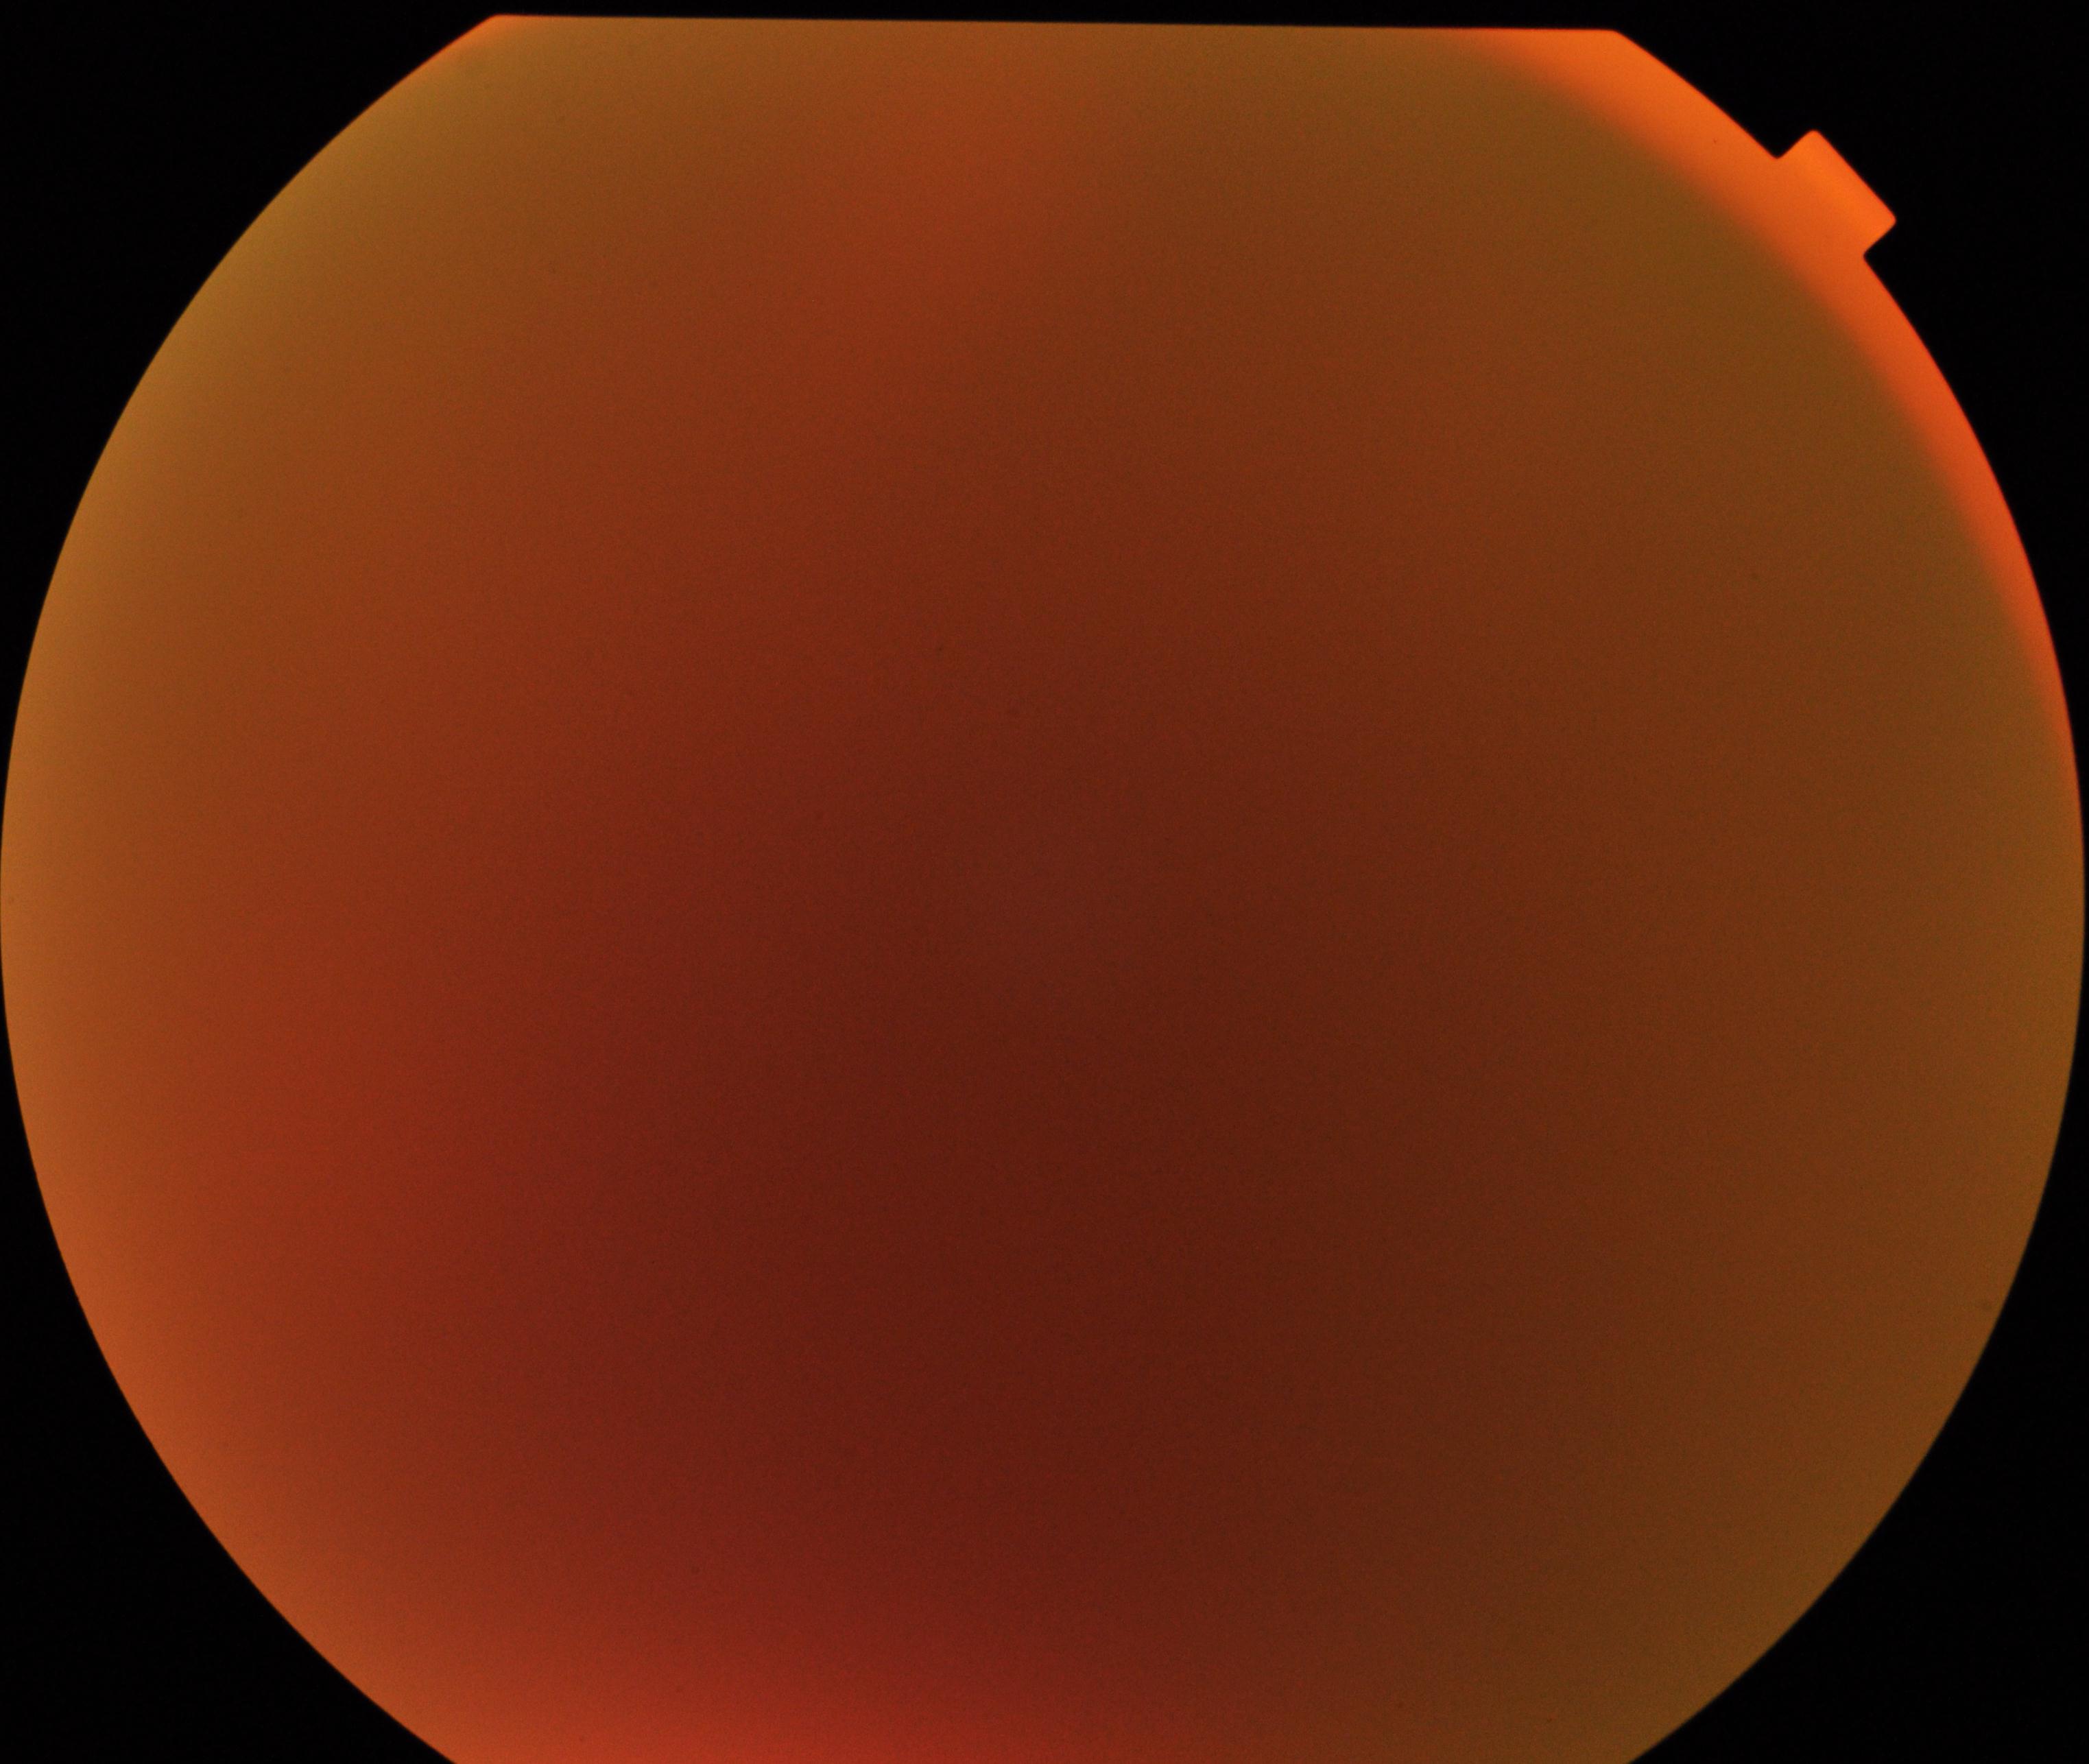 Blurred fundus image with substantial obscuration of retinal landmarks. No proliferative diabetic retinopathy identified.